1924 by 1556 pixels · retinal fundus photograph:
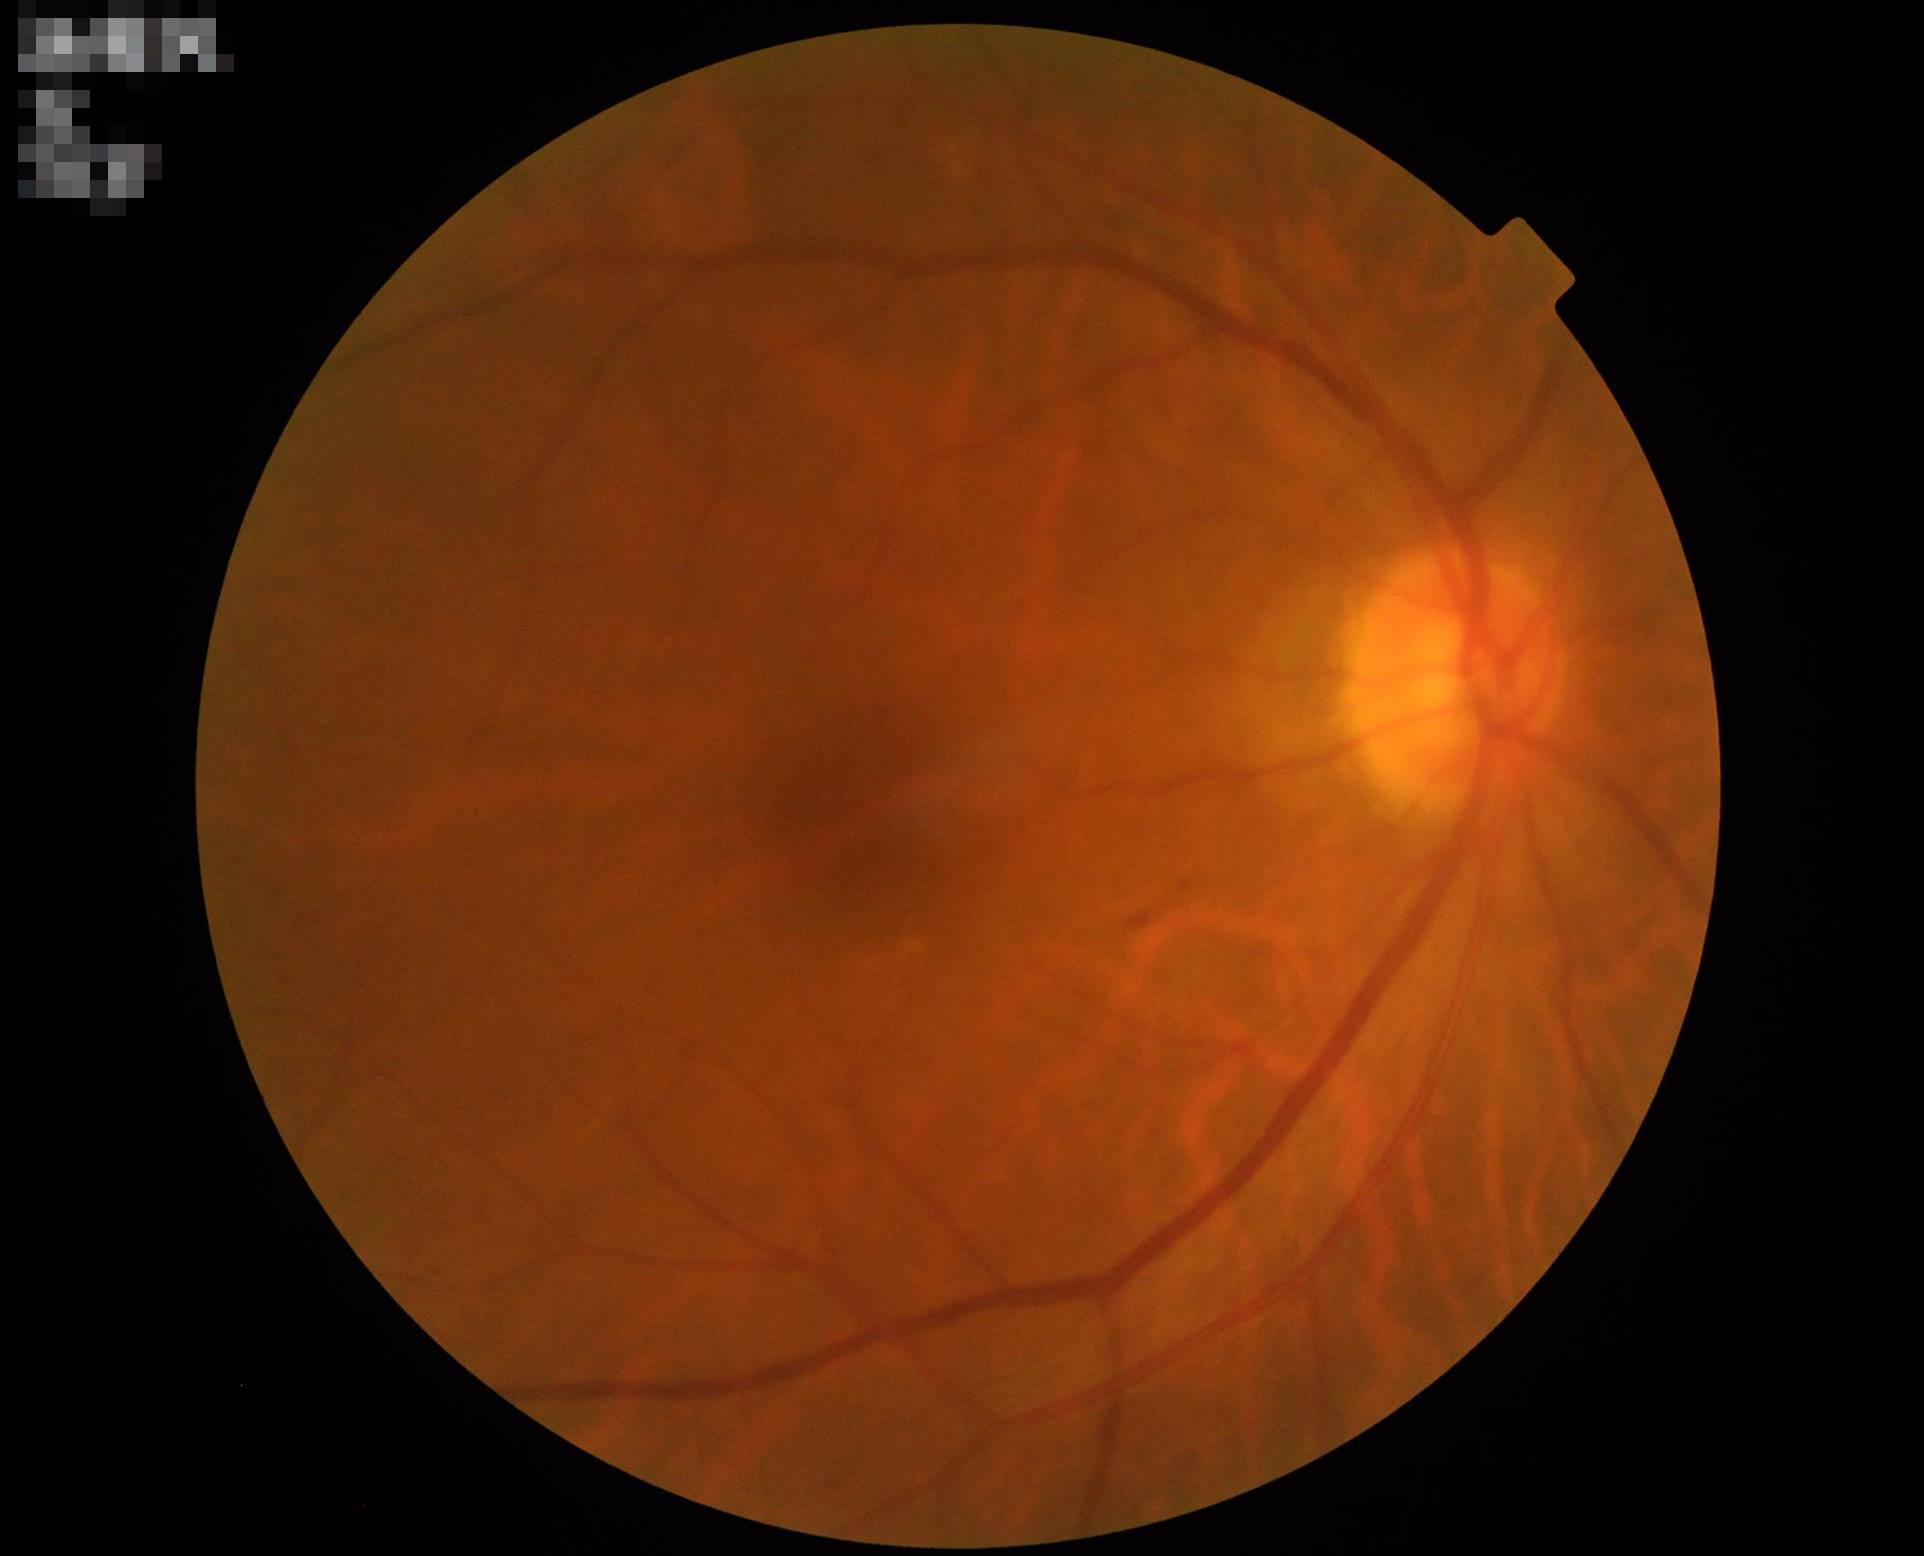 Illumination is even. Acceptable image quality. Optic disc, vessels, and background are in focus.